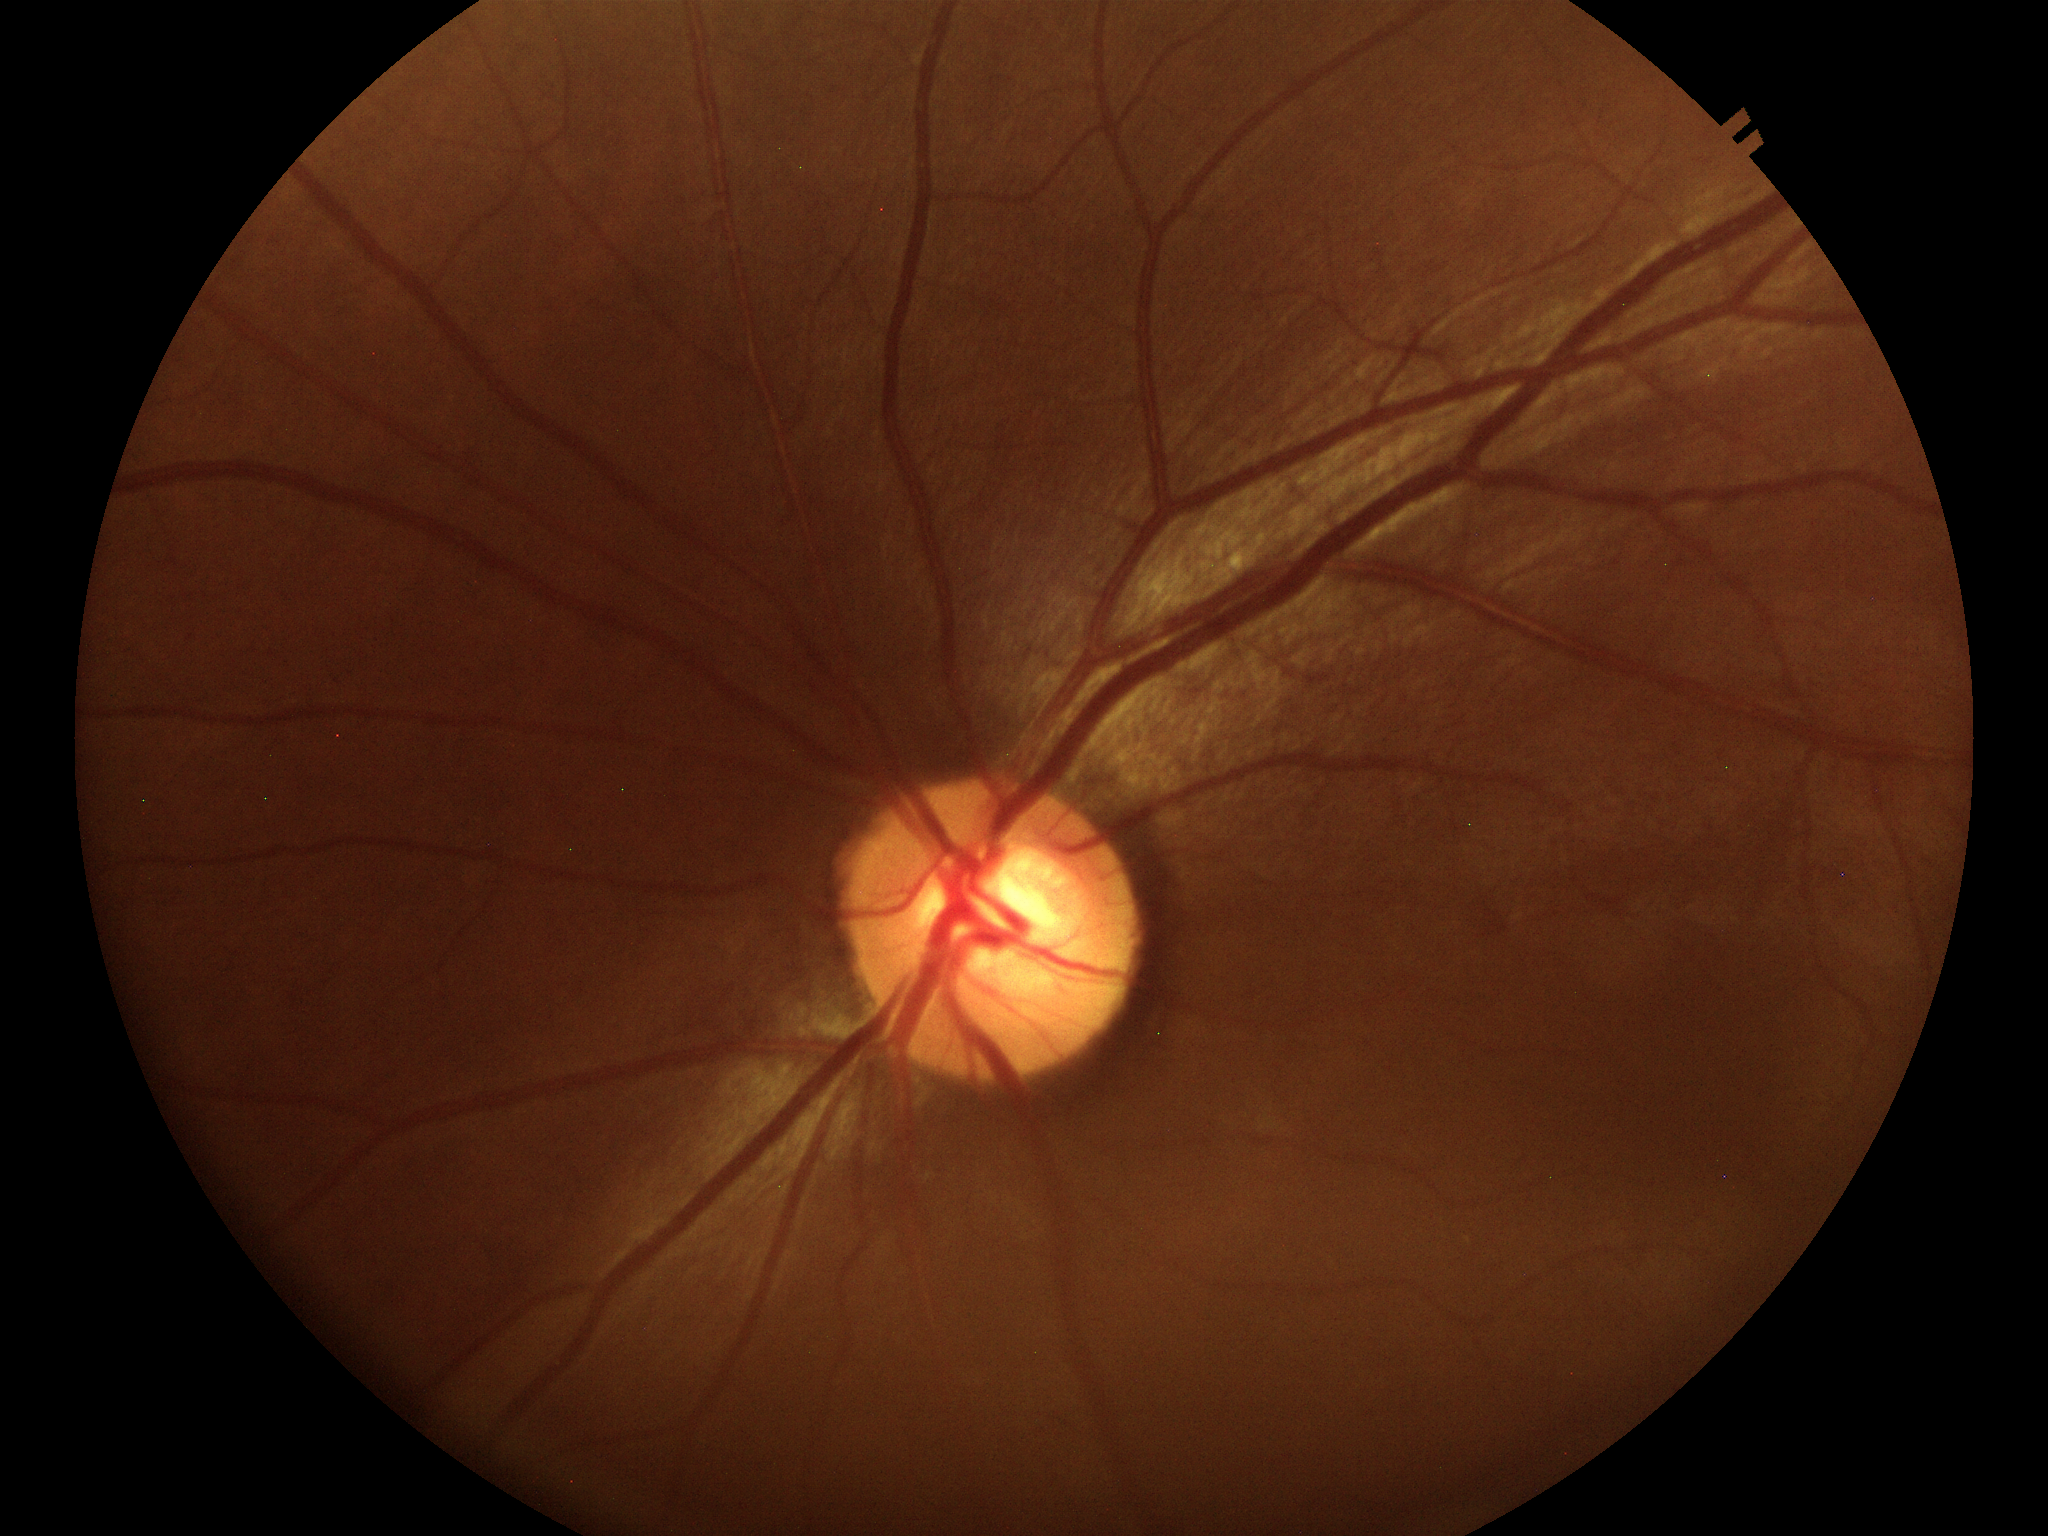
- Glaucoma assessment · no suspicious findings
- vertical cup-to-disc ratio · 0.55
- horizontal CDR · 0.62